Fundus photo, 512 by 512 pixels: 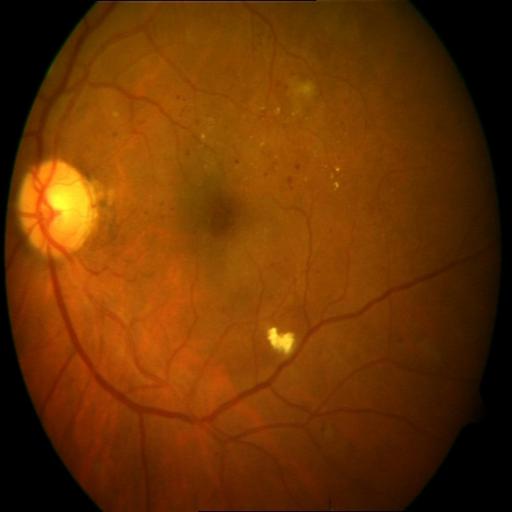 Findings: exudation (EDN).